Camera: Clarity RetCam 3 (130° FOV) · infant wide-field retinal image: 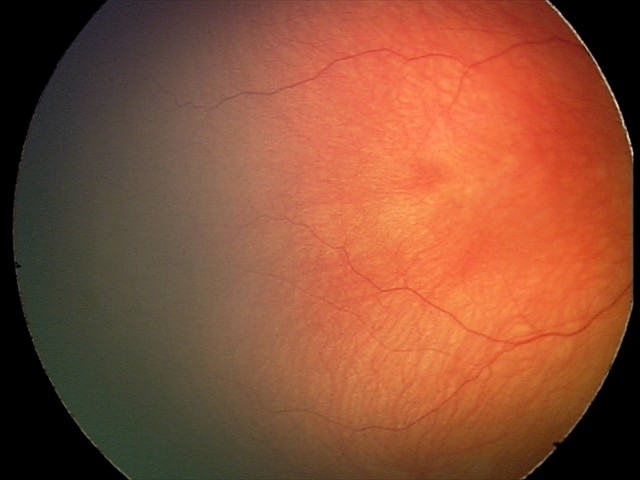
Diagnosis from this screening exam: retinal hemorrhages.